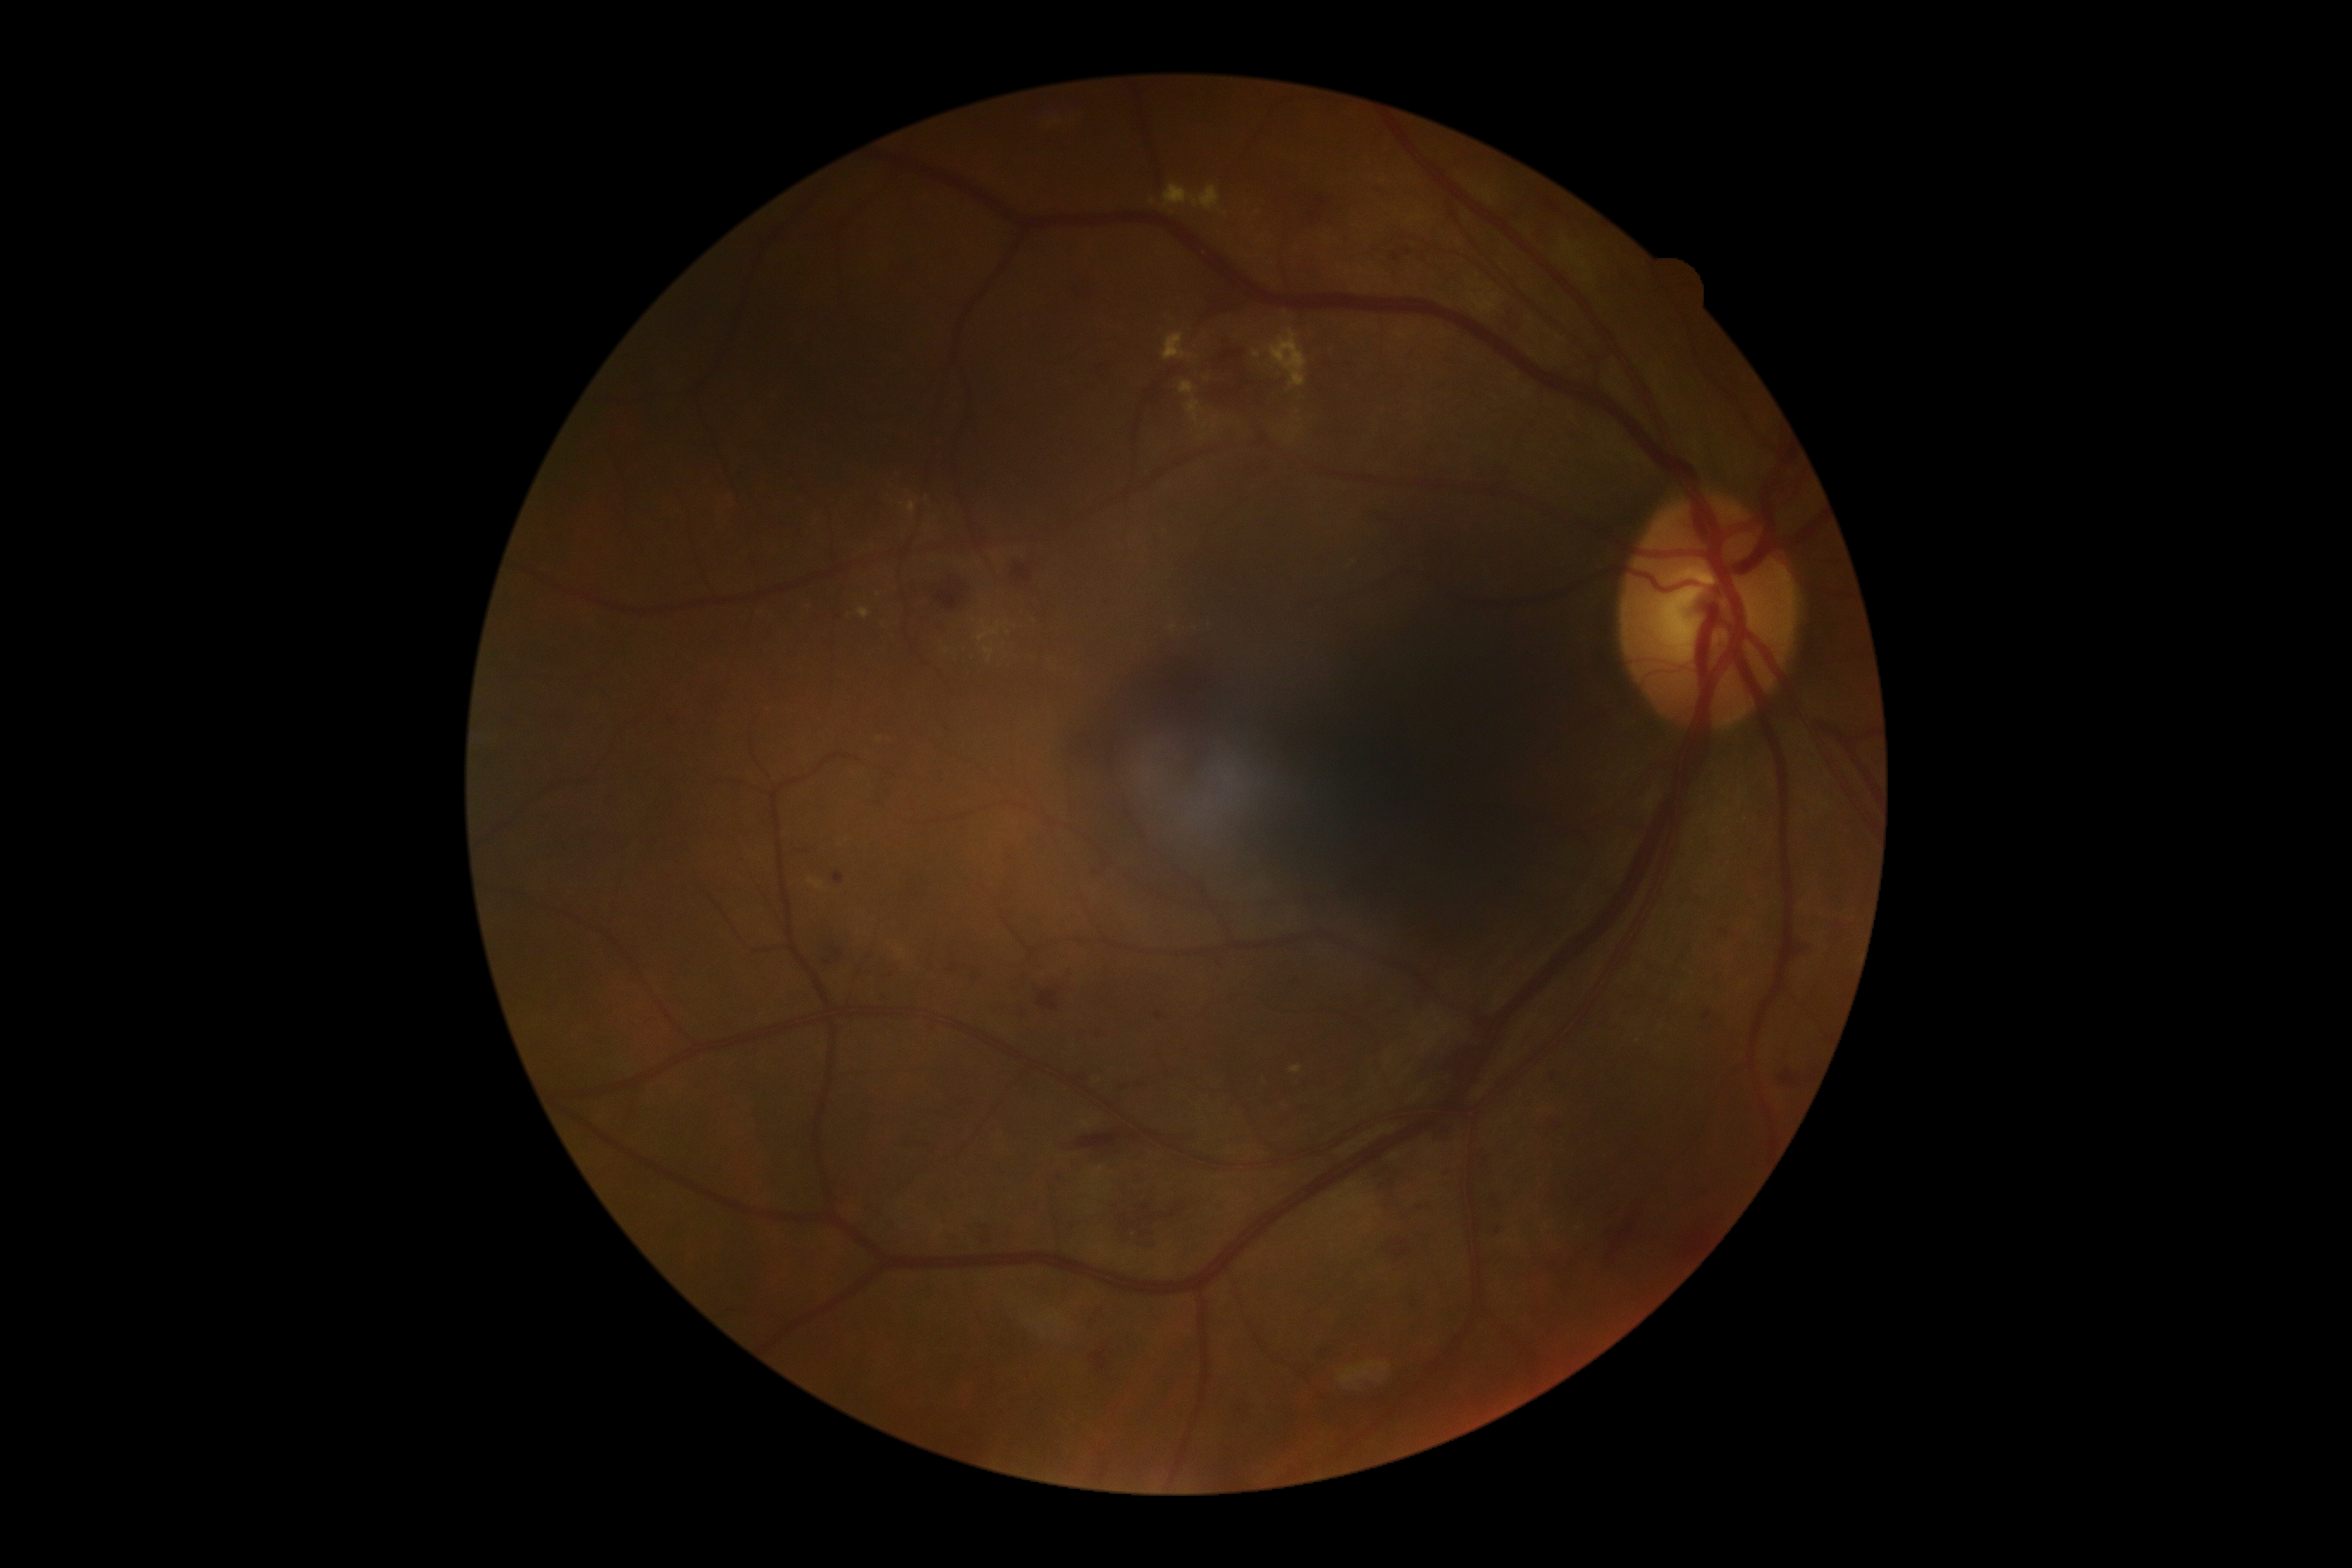
partial: true
dr_grade: 2
lesions:
  ma:
    - bbox(1390, 254, 1399, 262)
    - bbox(1120, 1086, 1129, 1091)
    - bbox(1703, 1012, 1712, 1020)
    - bbox(835, 873, 845, 885)
    - bbox(1404, 248, 1412, 255)
    - bbox(1156, 1012, 1163, 1020)
  ma_small_centers:
    - [1060, 1180]
  he:
    - bbox(1032, 976, 1072, 1008)
    - bbox(1206, 391, 1234, 408)
    - bbox(1113, 1191, 1194, 1249)
    - bbox(1603, 1203, 1641, 1261)
    - bbox(1550, 1117, 1562, 1134)
    - bbox(878, 989, 885, 1007)
    - bbox(1075, 1132, 1122, 1151)
    - bbox(1770, 1062, 1815, 1086)
    - bbox(1435, 1127, 1452, 1141)
    - bbox(1547, 200, 1559, 212)
    - bbox(1093, 1352, 1108, 1371)
    - bbox(1545, 1074, 1559, 1086)
    - bbox(1498, 303, 1521, 333)
    - bbox(885, 965, 897, 981)
    - bbox(1309, 216, 1316, 224)
    - bbox(1220, 350, 1244, 364)
    - bbox(835, 948, 843, 959)
    - bbox(1115, 1081, 1148, 1093)
  he_small_centers:
    - [955, 968]
    - [1132, 1136]
  ex:
    - bbox(1163, 185, 1222, 211)
    - bbox(1180, 383, 1194, 396)
    - bbox(1253, 350, 1261, 358)
    - bbox(1187, 400, 1199, 424)
    - bbox(809, 878, 824, 890)
    - bbox(1199, 436, 1208, 441)
    - bbox(857, 609, 871, 618)
    - bbox(1290, 1067, 1302, 1074)
    - bbox(1268, 329, 1309, 388)
    - bbox(979, 625, 1001, 642)
    - bbox(1163, 333, 1185, 362)
    - bbox(984, 647, 995, 661)
    - bbox(907, 501, 916, 513)
  ex_small_centers:
    - [1215, 426]
    - [1191, 357]
    - [1206, 425]
  se: []